2352 x 1568 pixels:
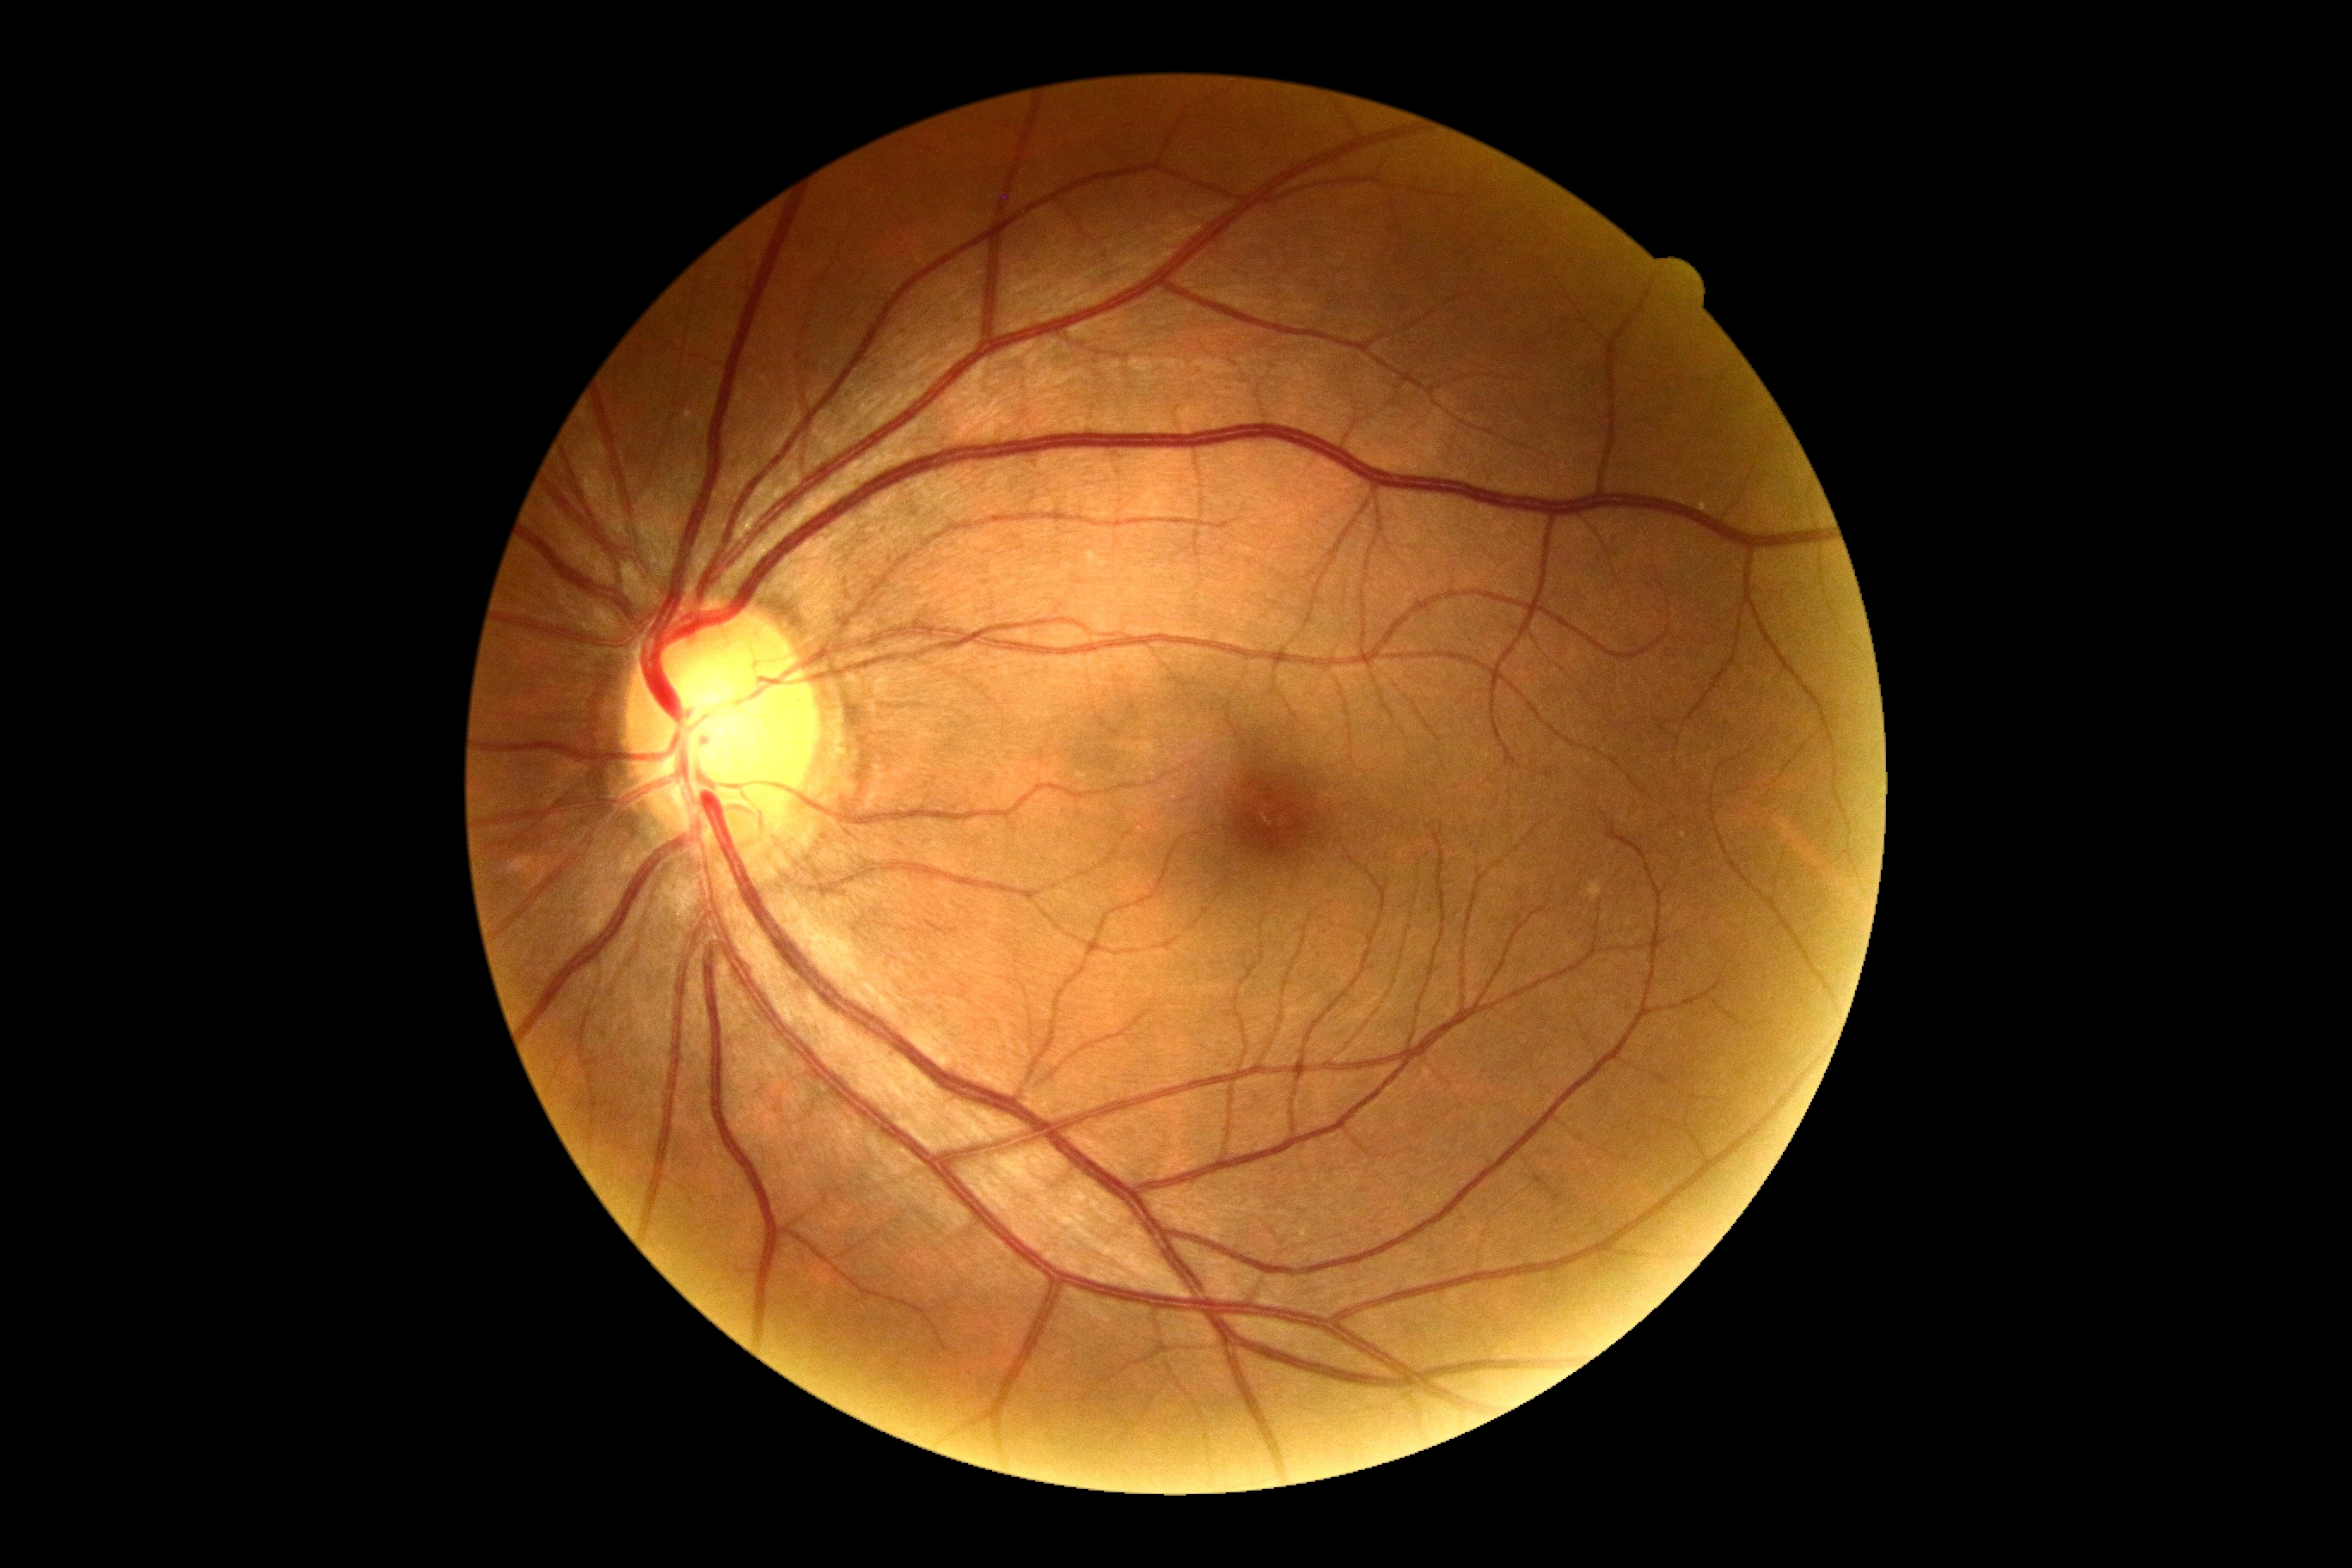
{"dr_impression": "no DR findings", "dr_grade": "0"}